Modified Davis classification: 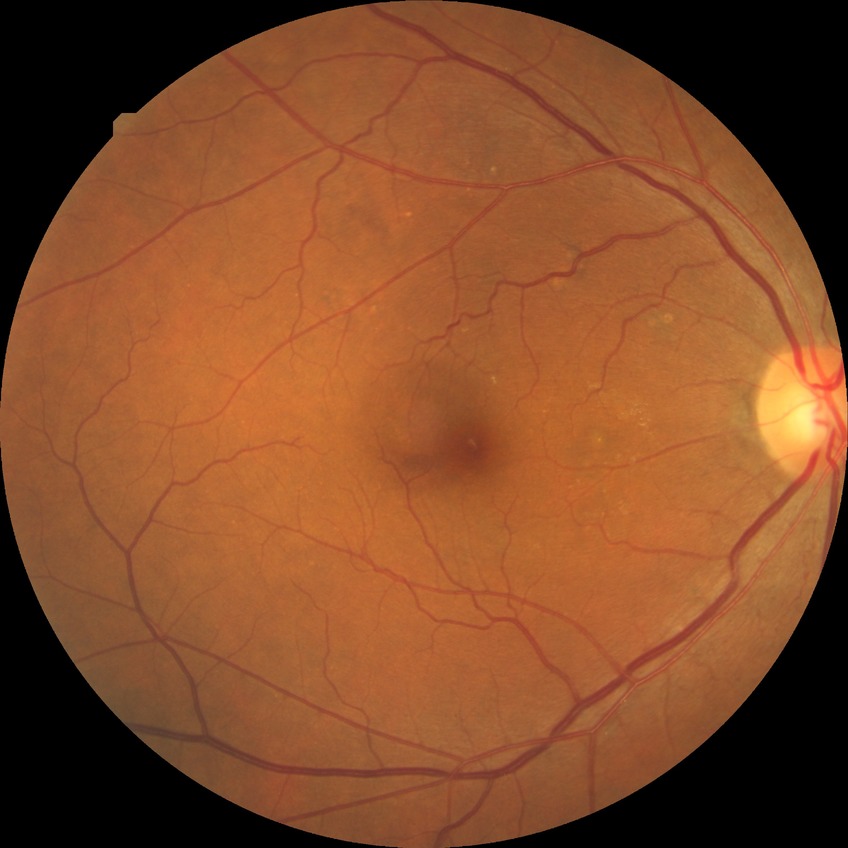
diabetic retinopathy (DR)@NDR (no diabetic retinopathy).